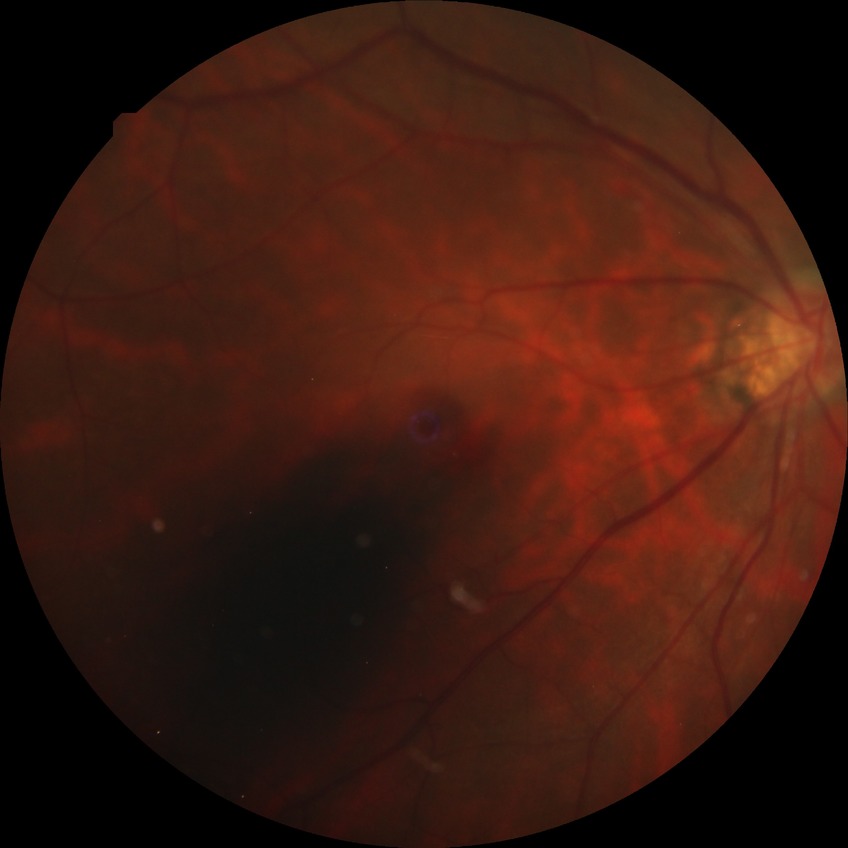 Diabetic retinopathy (DR) is NDR (no diabetic retinopathy).